NIDEK AFC-230 fundus camera · color fundus image: 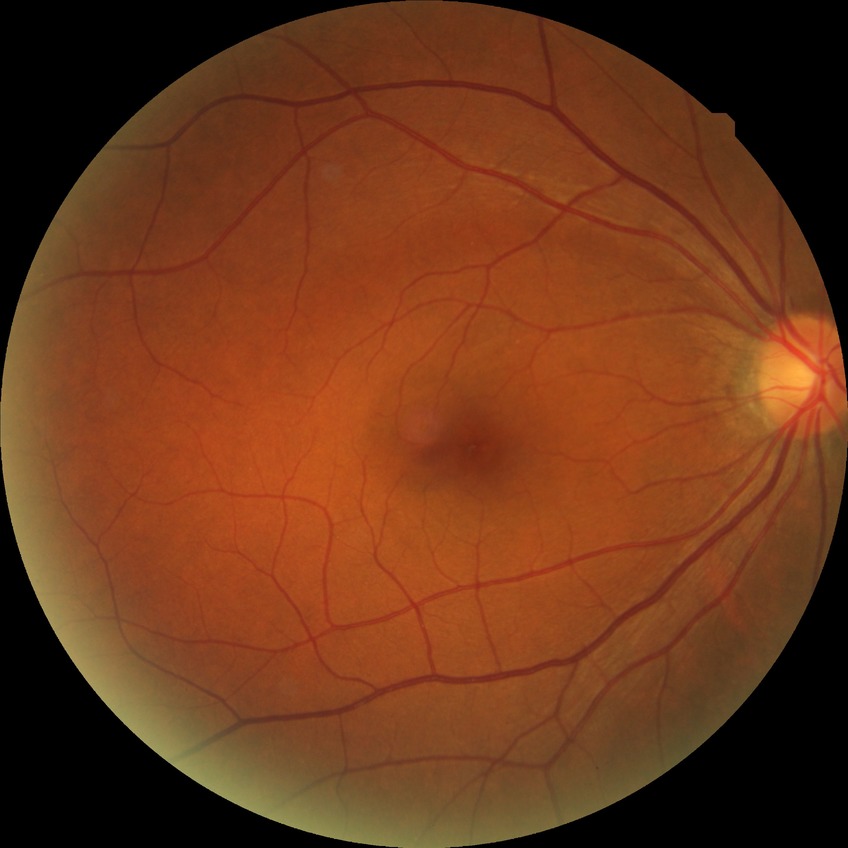

diabetic retinopathy (DR)@NDR (no diabetic retinopathy).